Nonmydriatic; acquired with a NIDEK AFC-230; 848 by 848 pixels; color fundus photograph; FOV: 45 degrees: 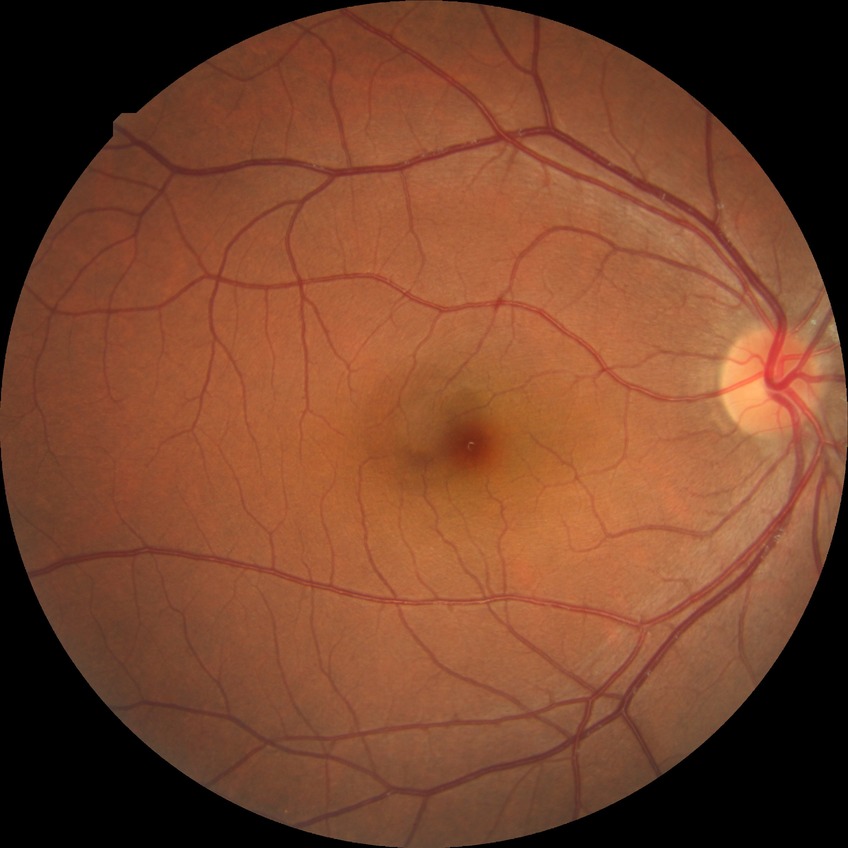

Diabetic retinopathy (DR) is no diabetic retinopathy (NDR).